45° field of view.
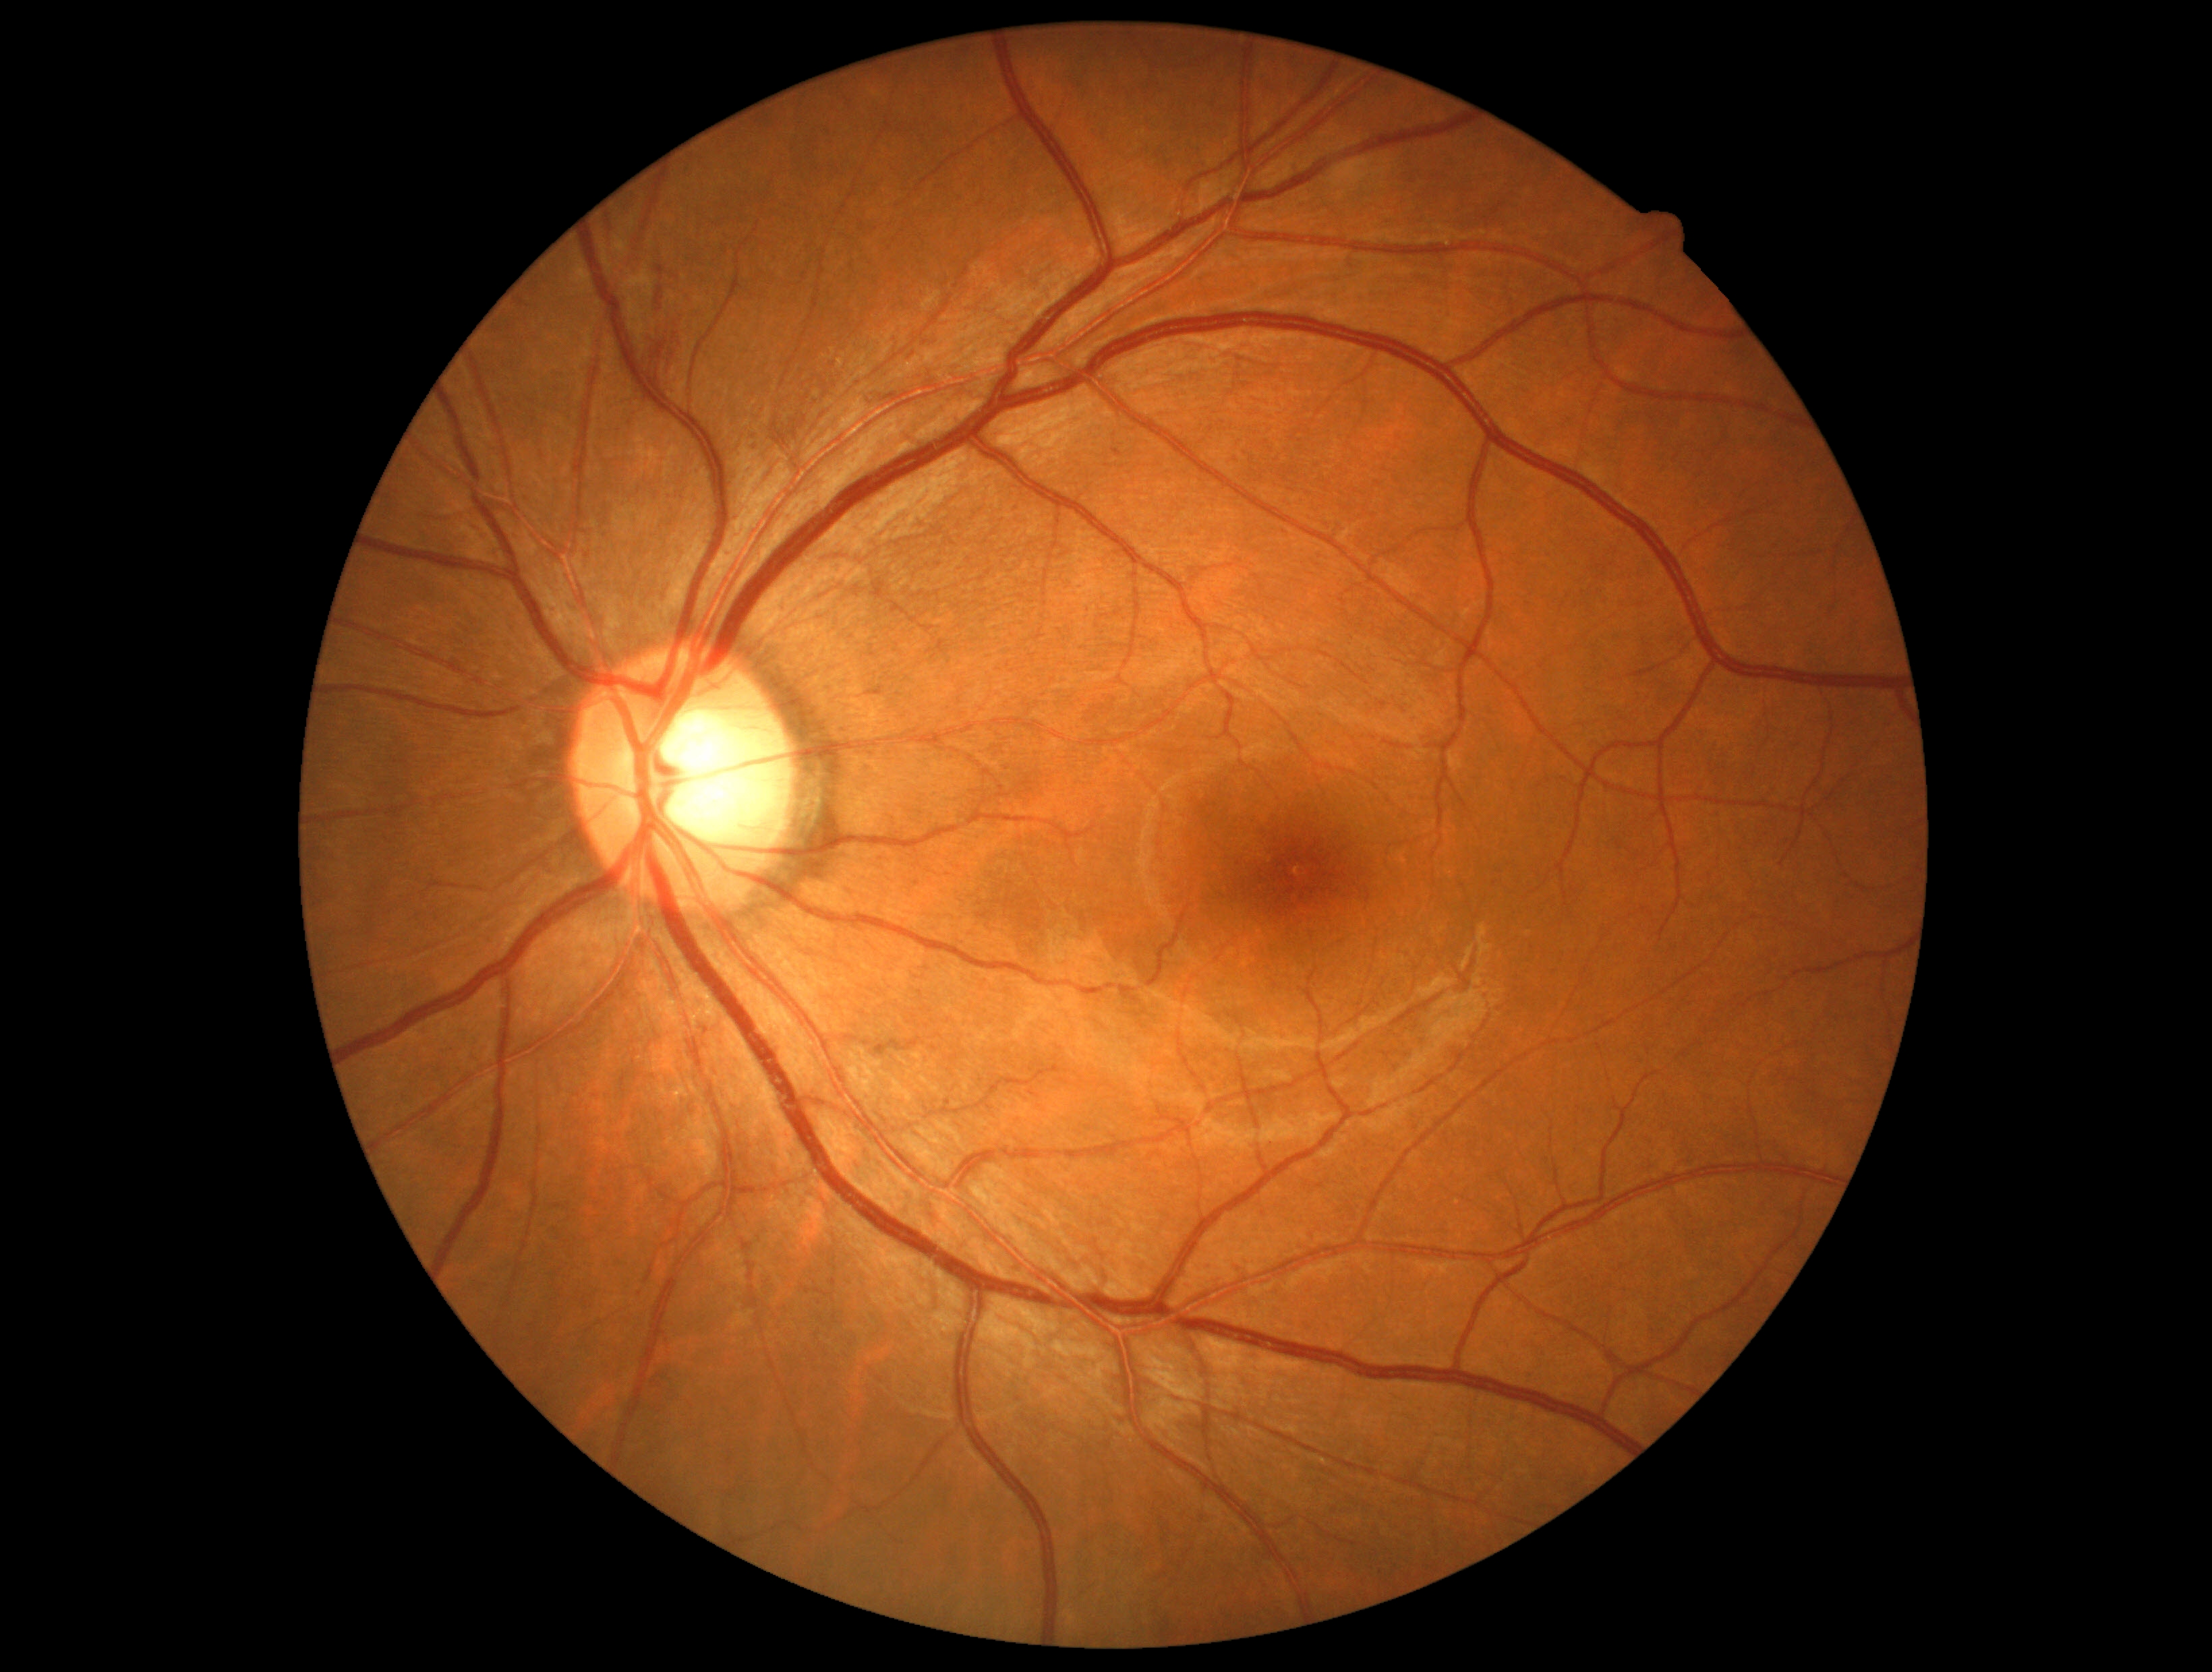
DR grade: 2.